Diabetic retinopathy graded by the modified Davis classification:
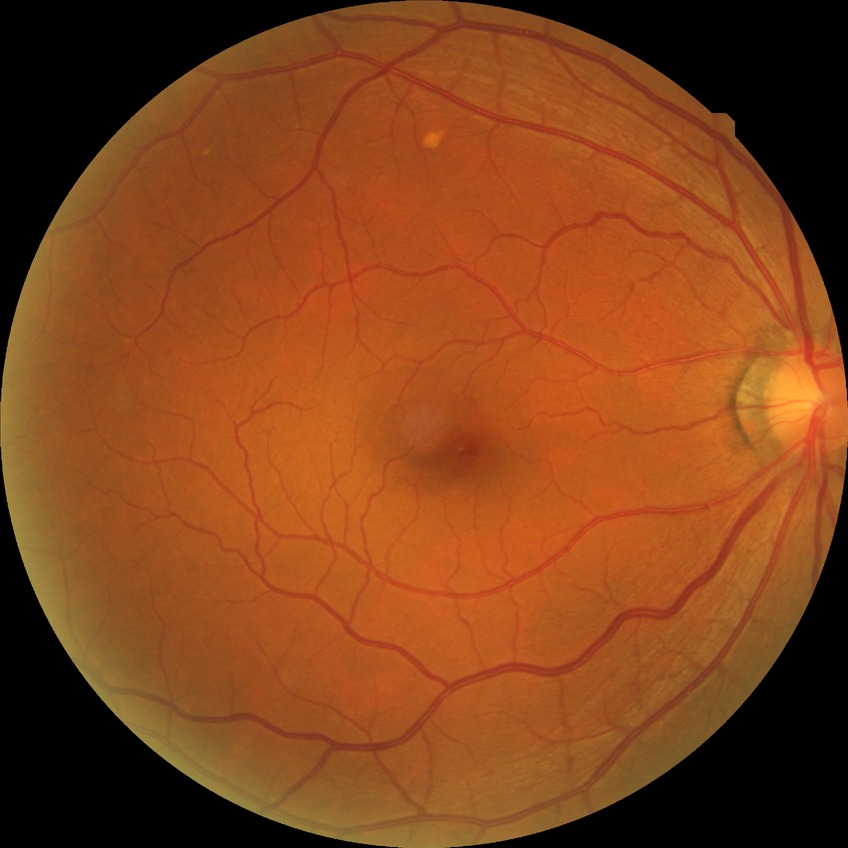

Diabetic retinopathy (DR) is NDR (no diabetic retinopathy).